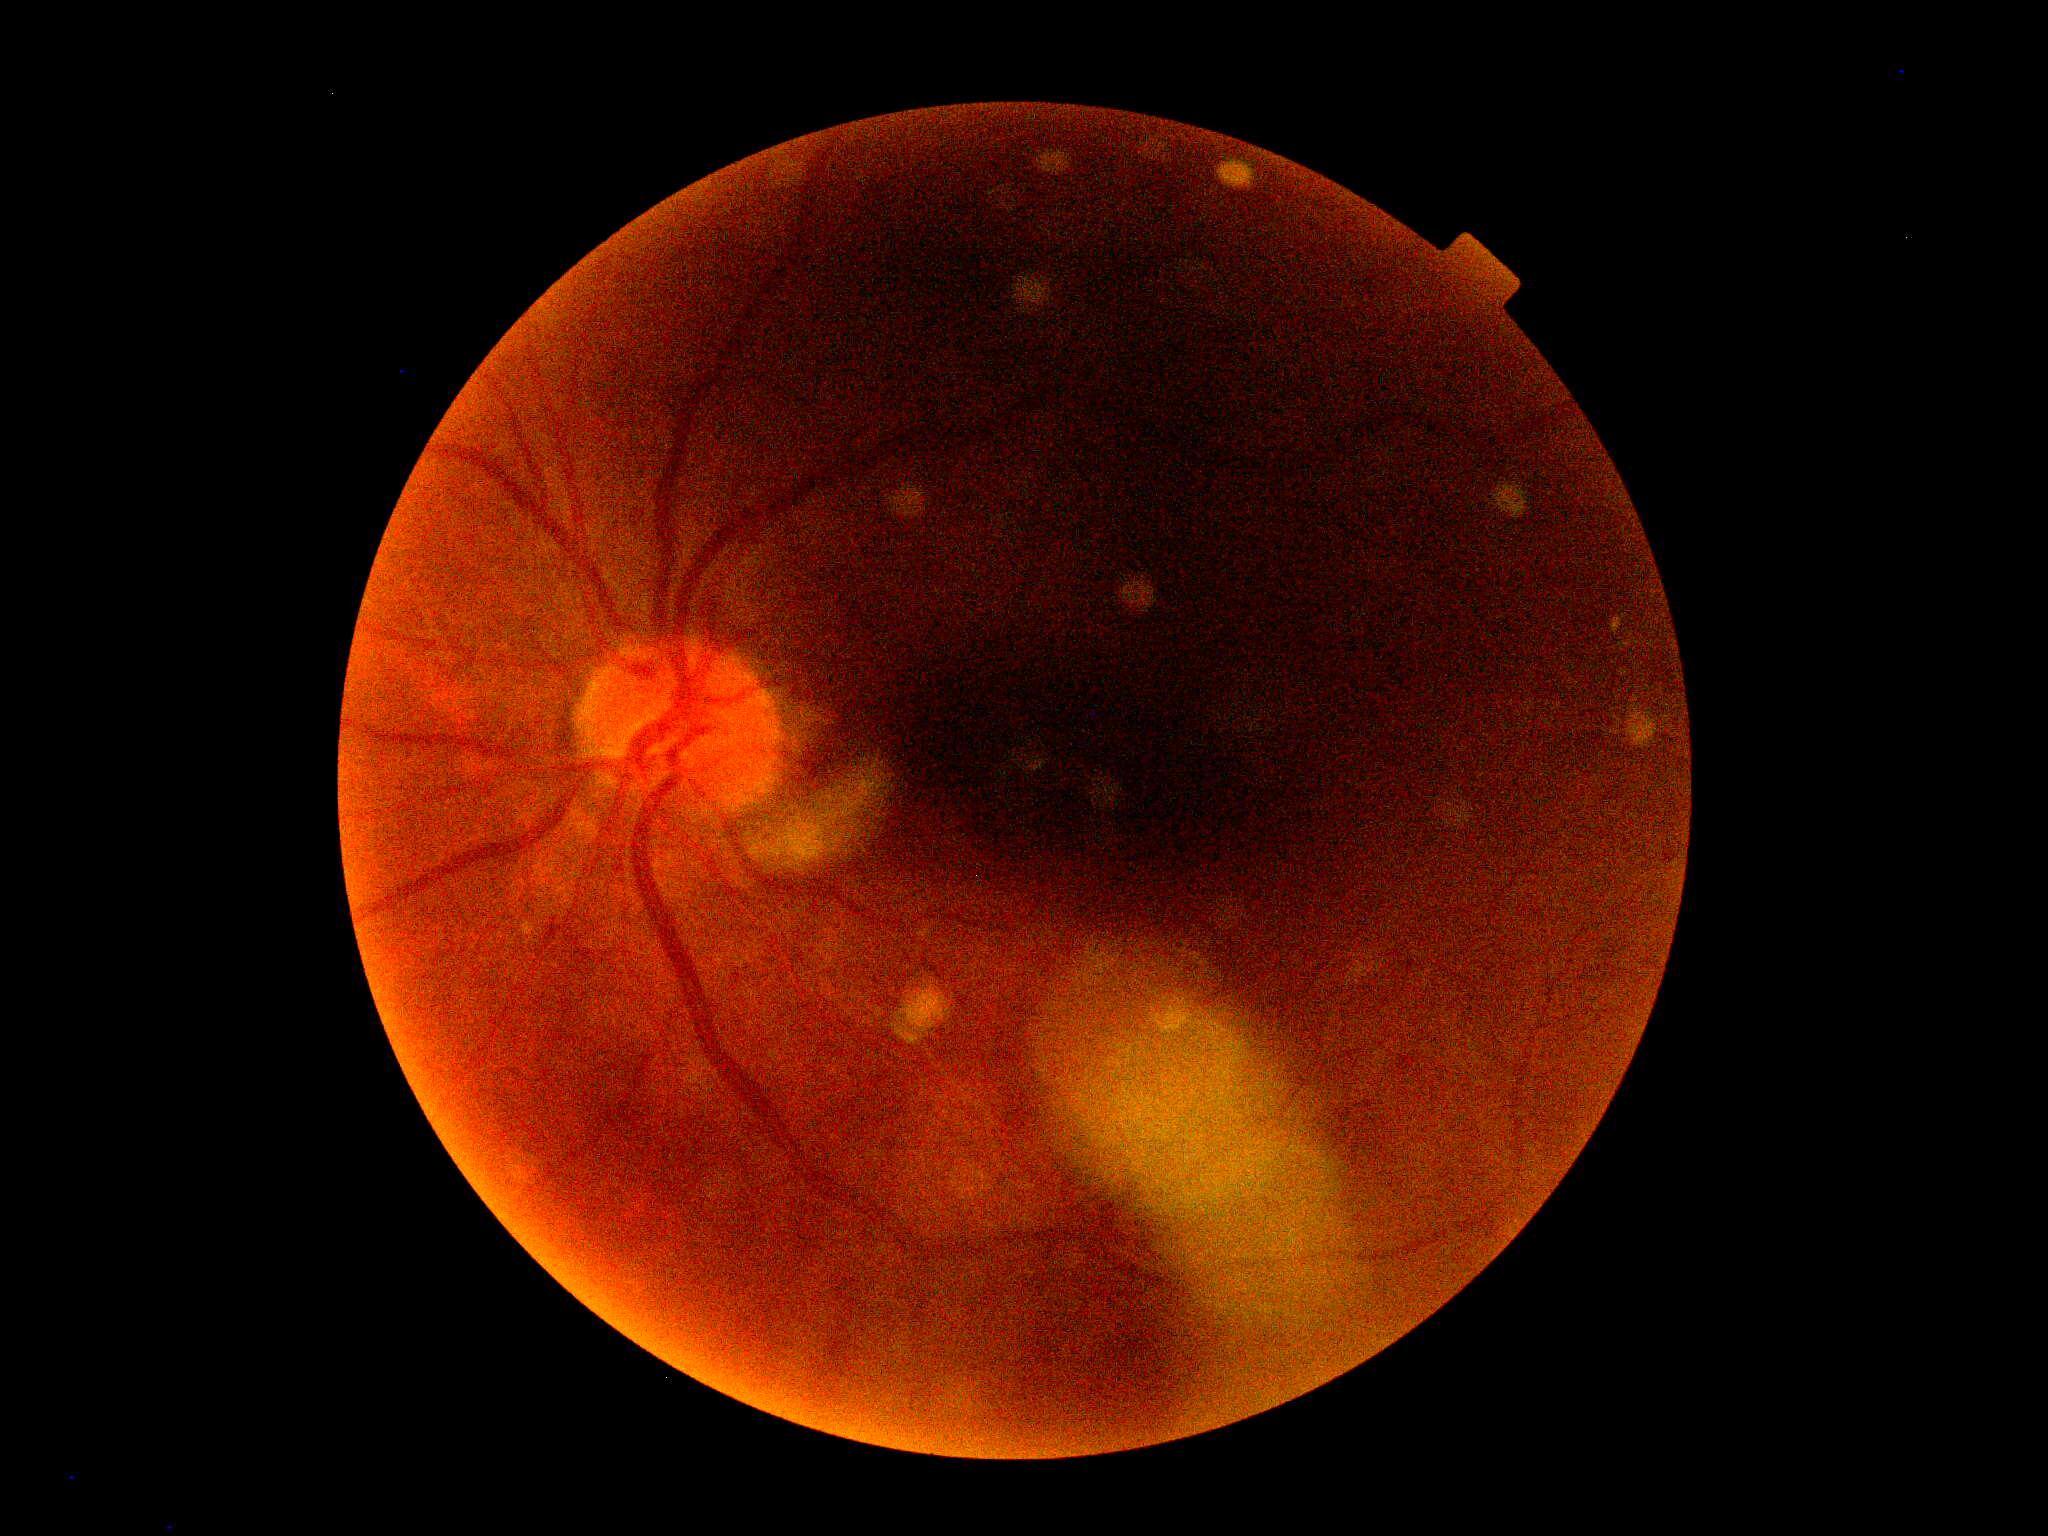
diabetic retinopathy (DR)=ungradable.